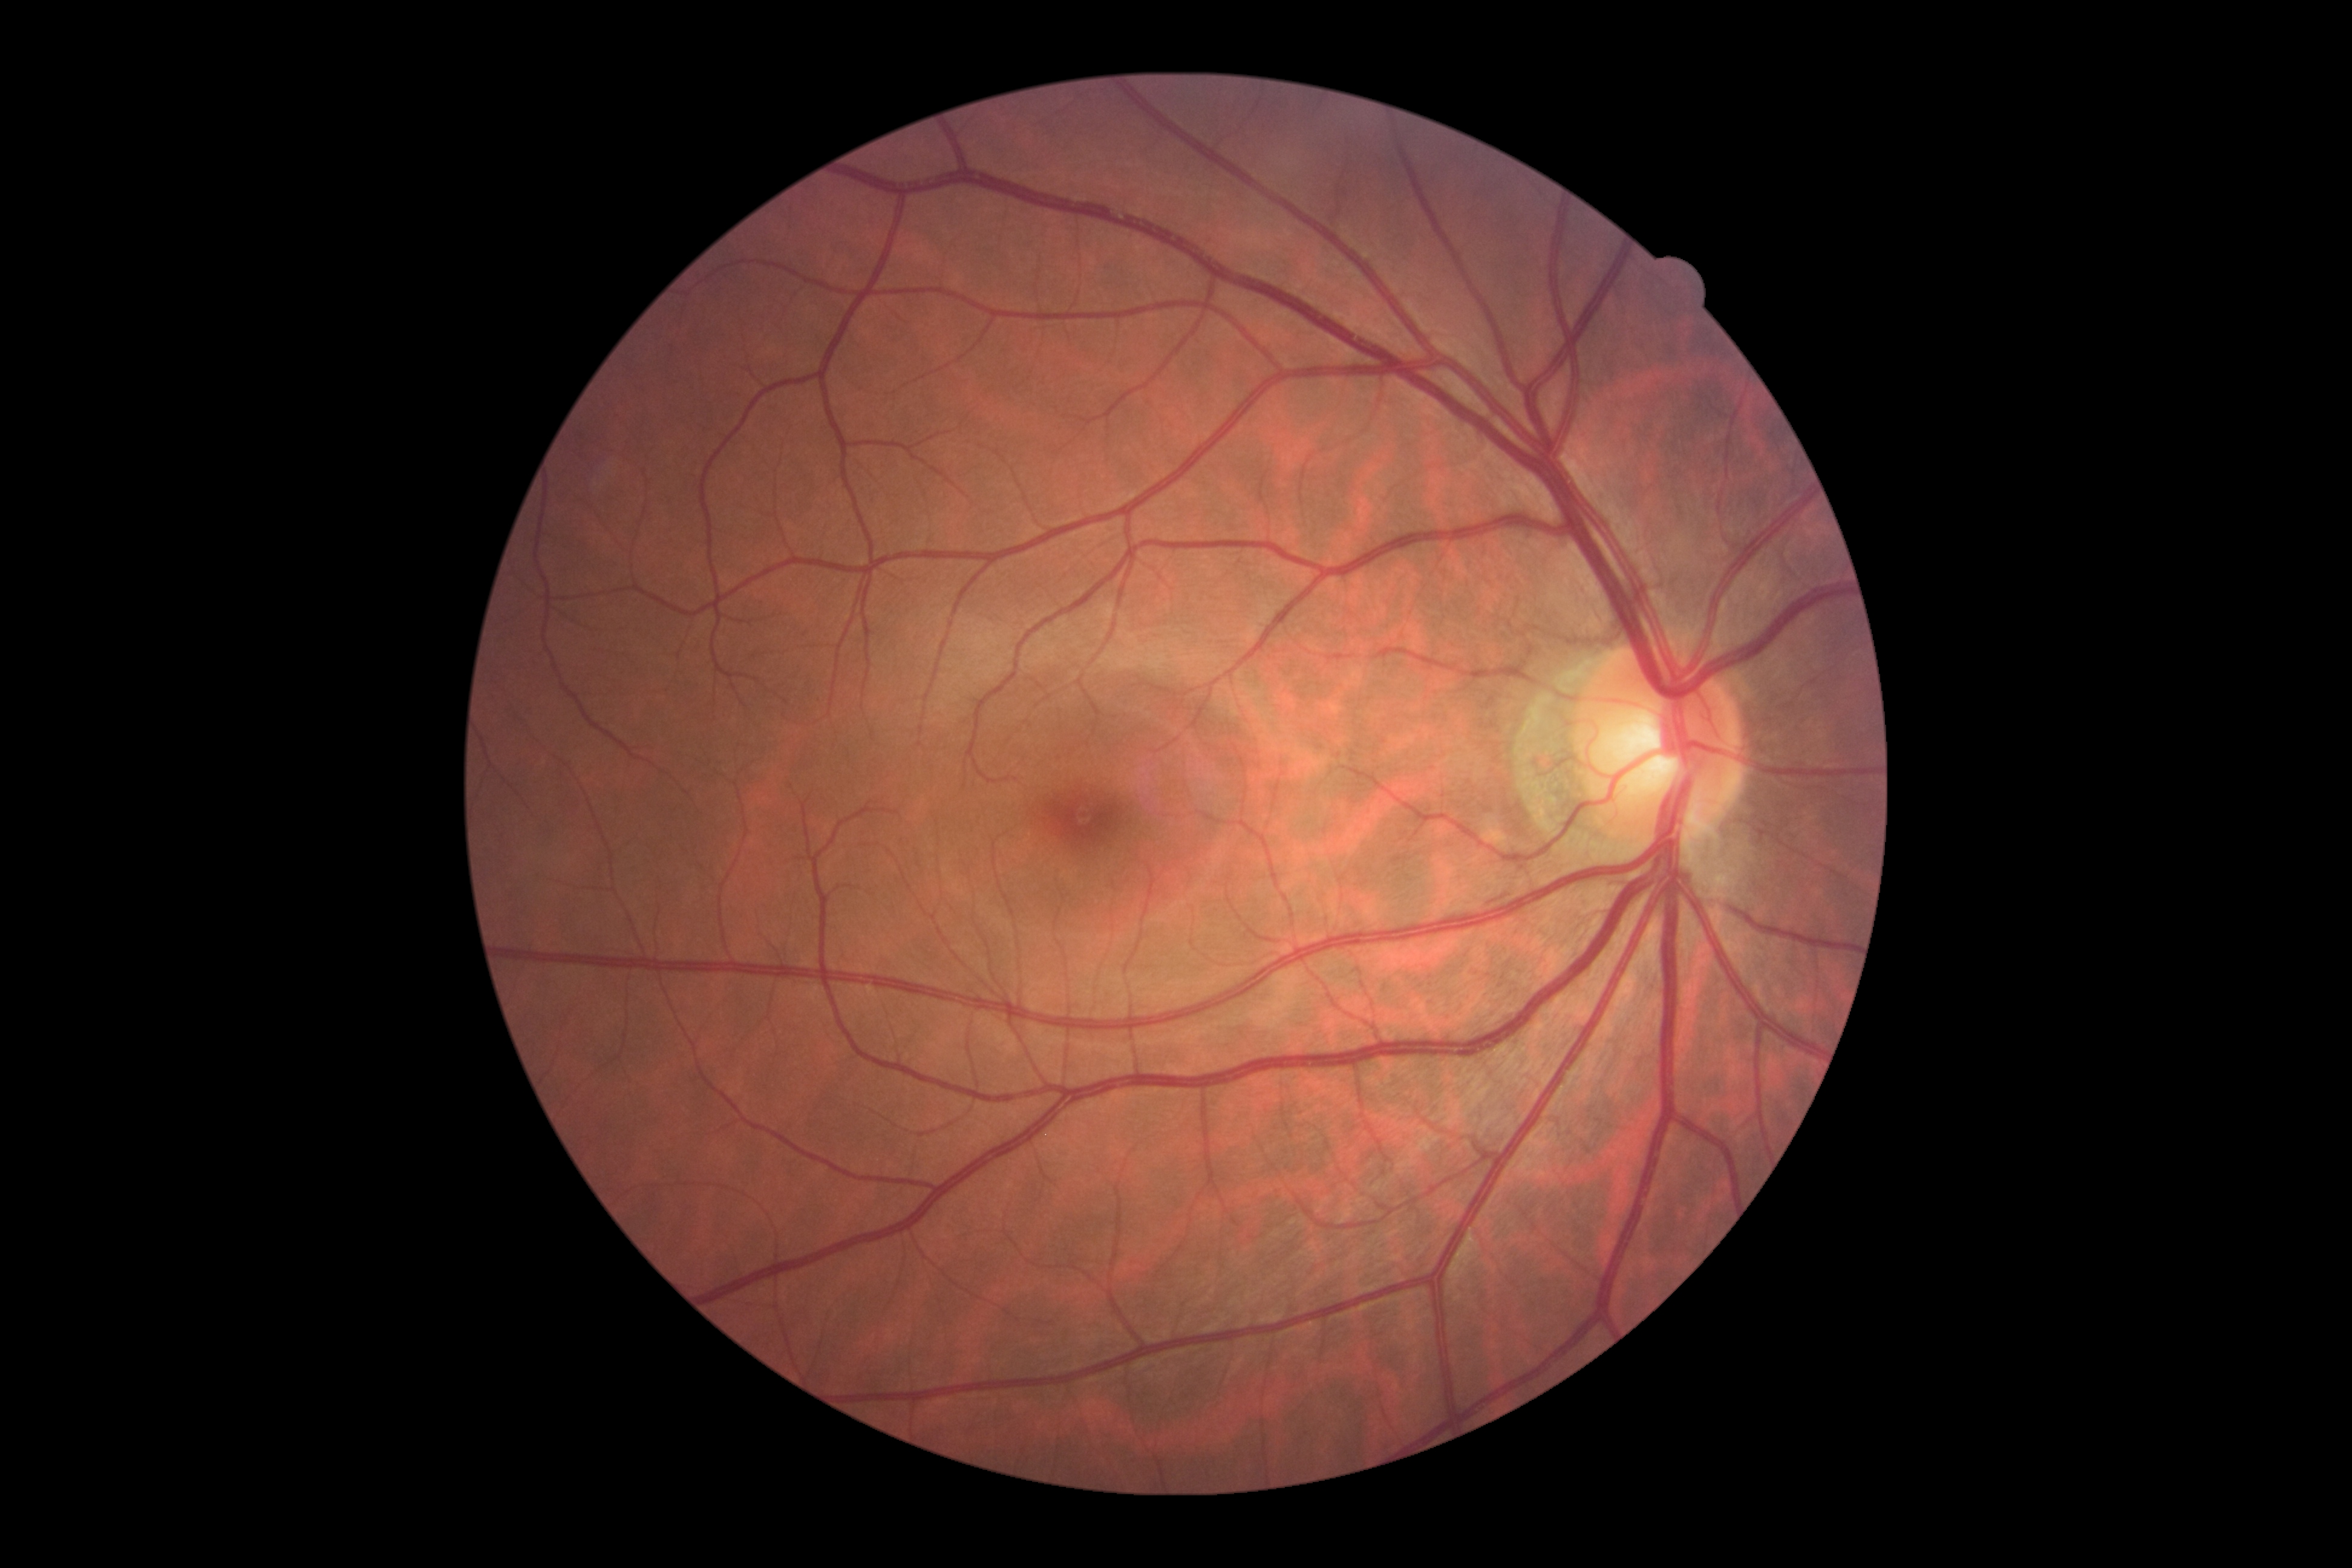
No diabetic retinal disease findings. DR grade: 0.